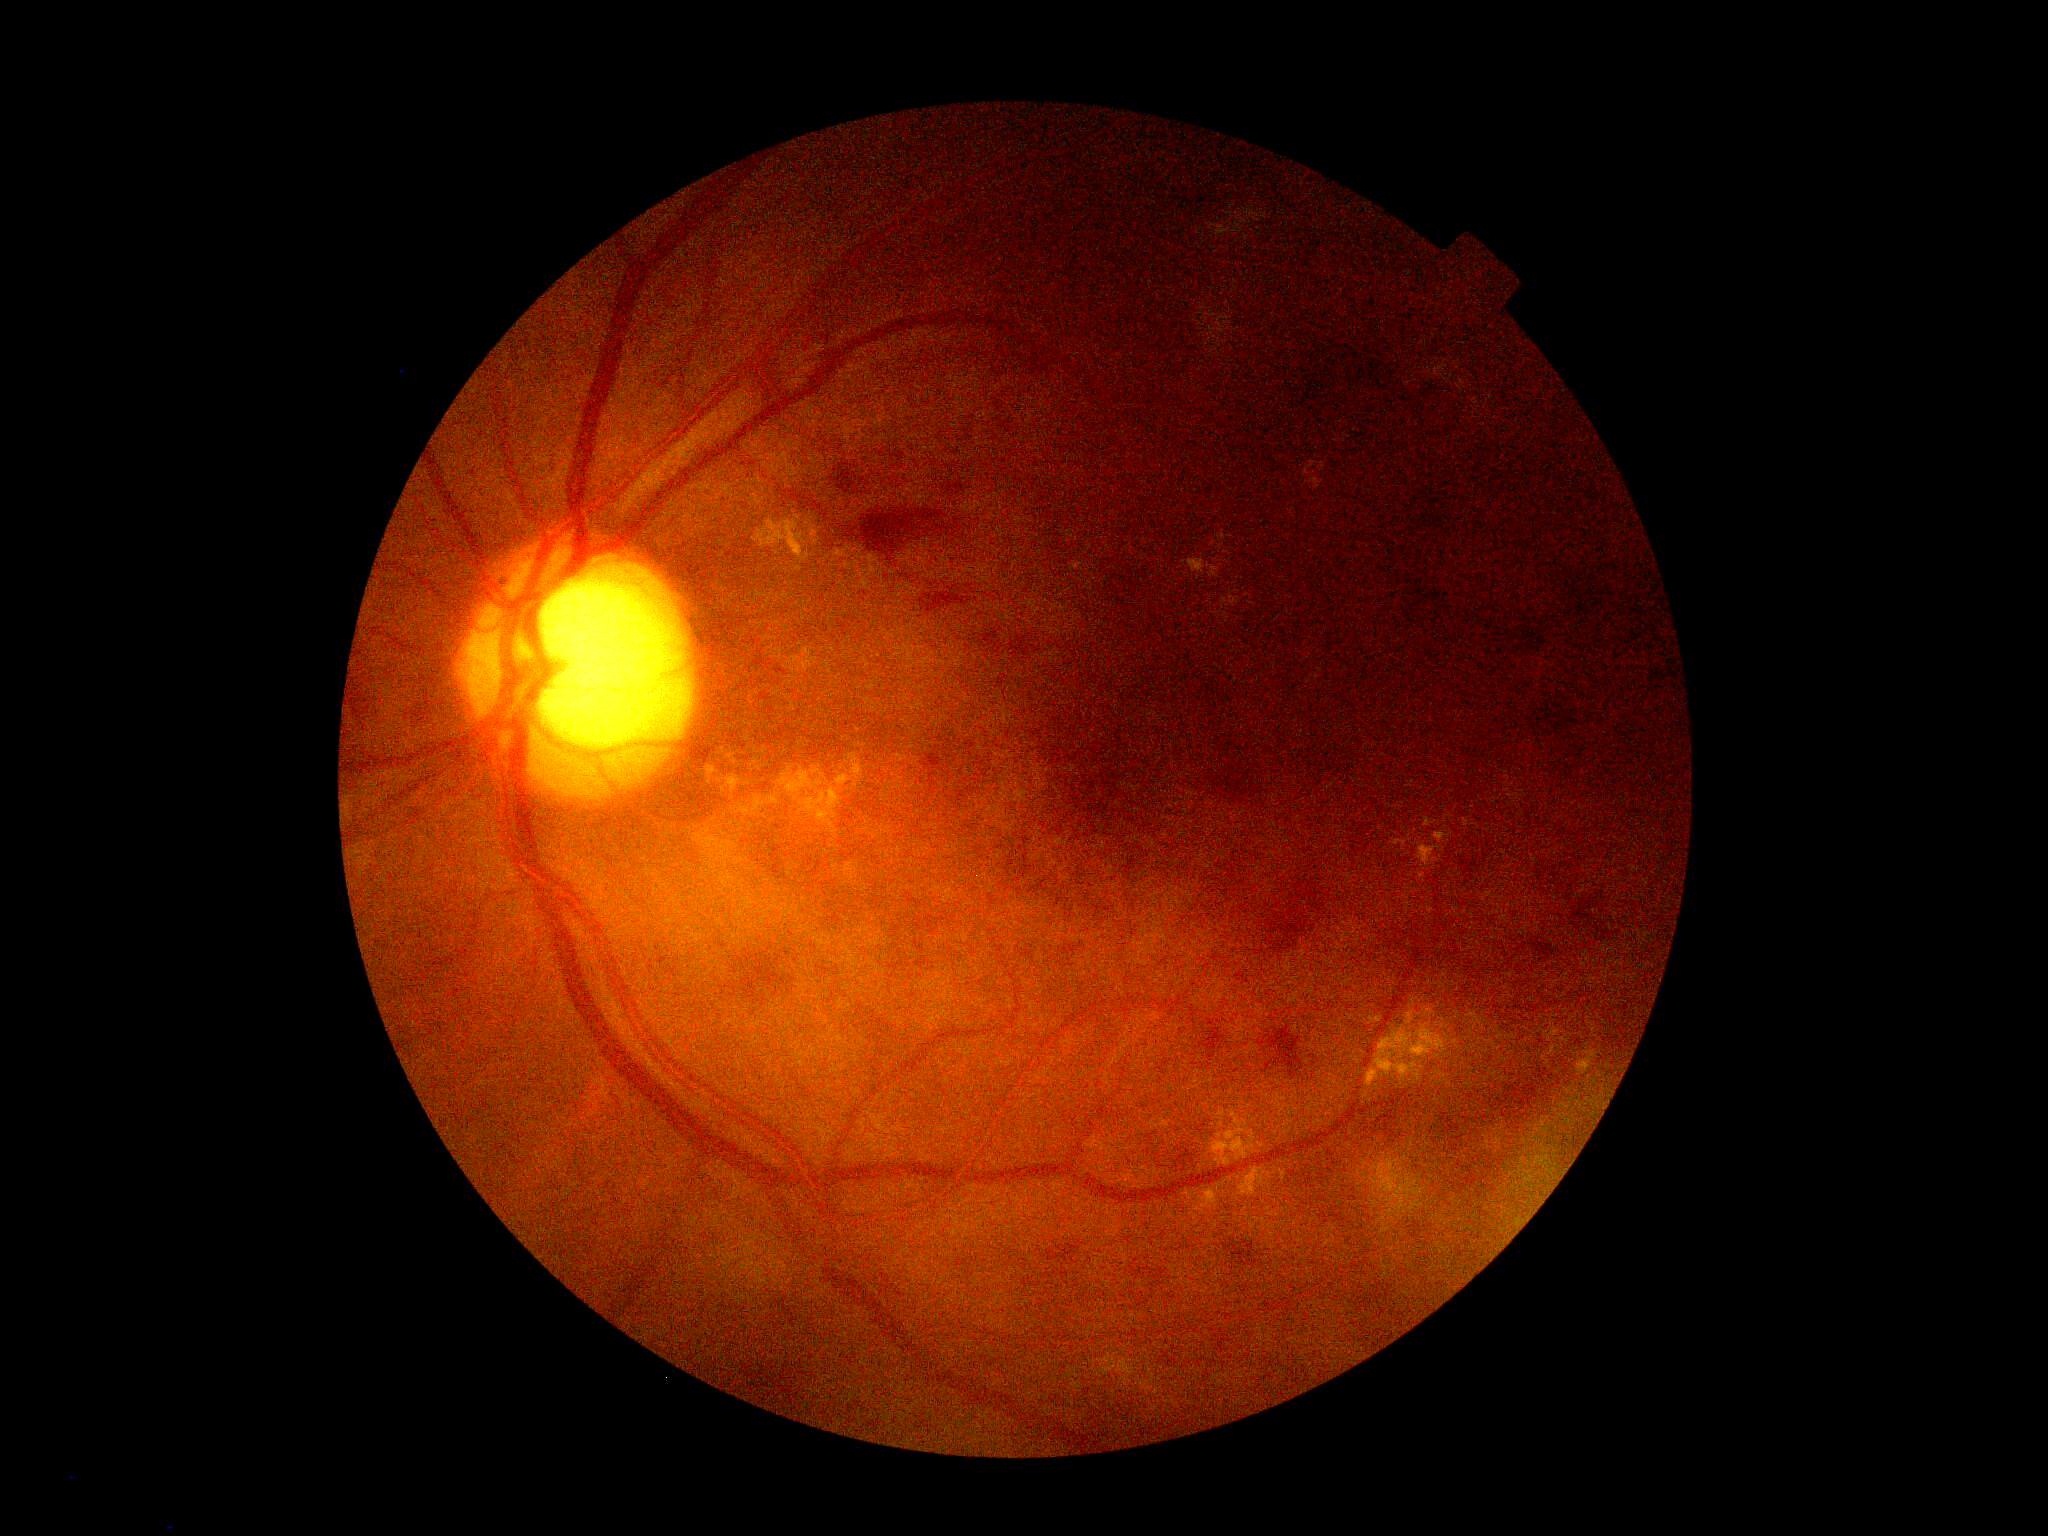

diabetic retinopathy (DR): grade 2 (moderate NPDR).